Infant wide-field retinal image; 1240 x 1240 pixels.
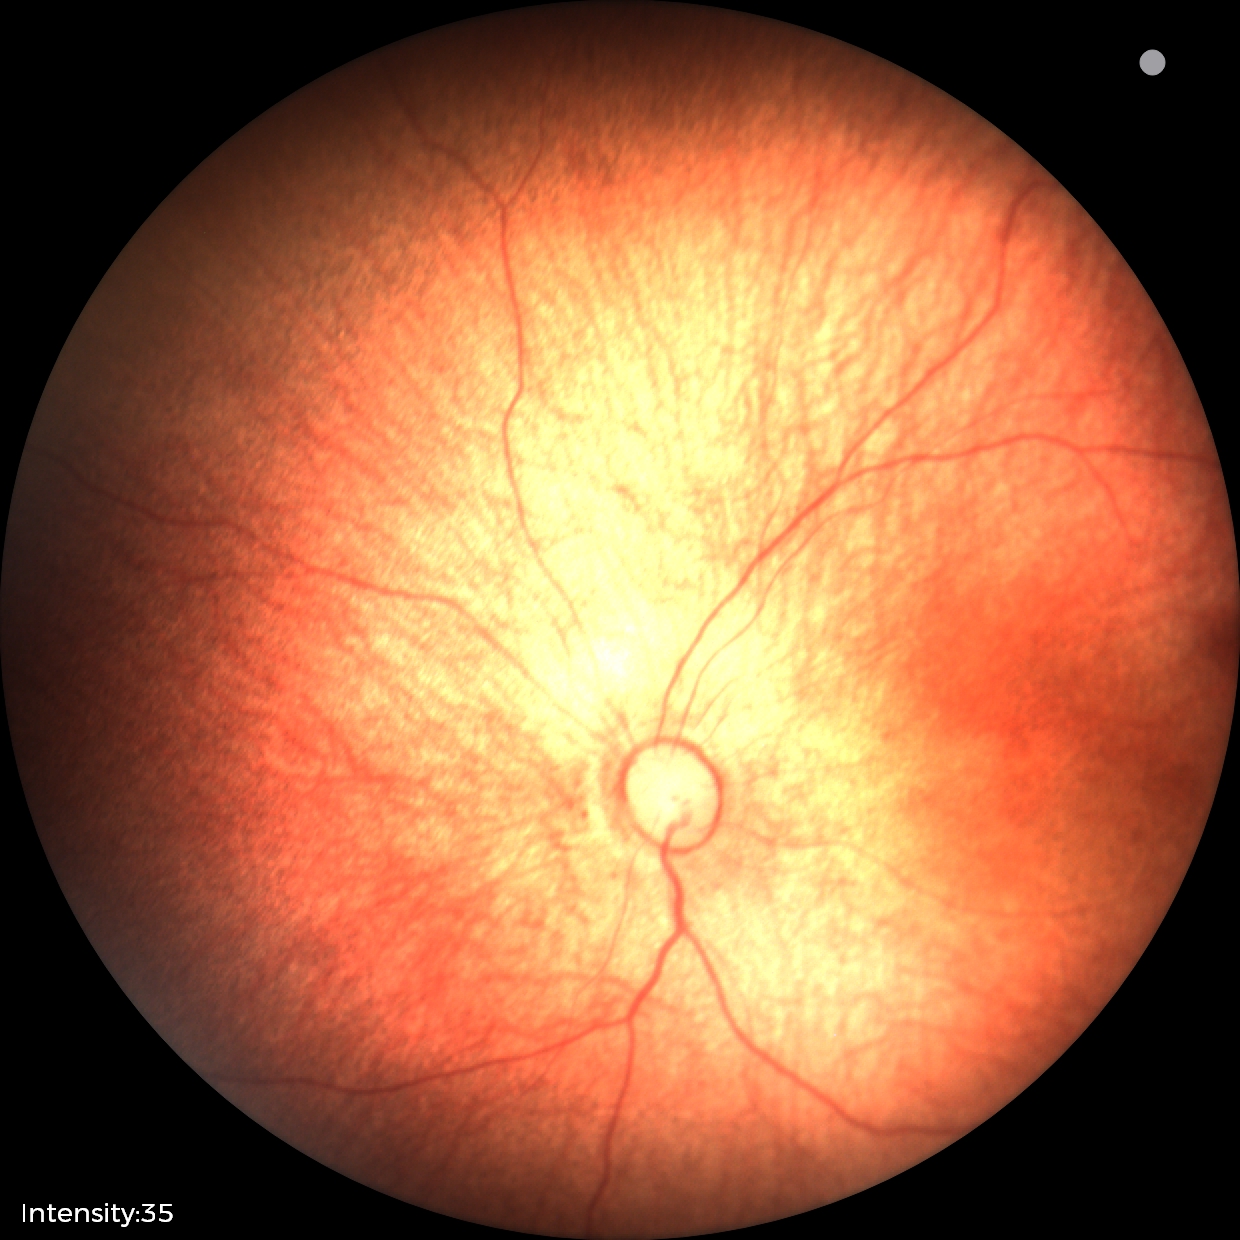

Assessment = normal retinal appearance.